2089x1764px, fundus photo — 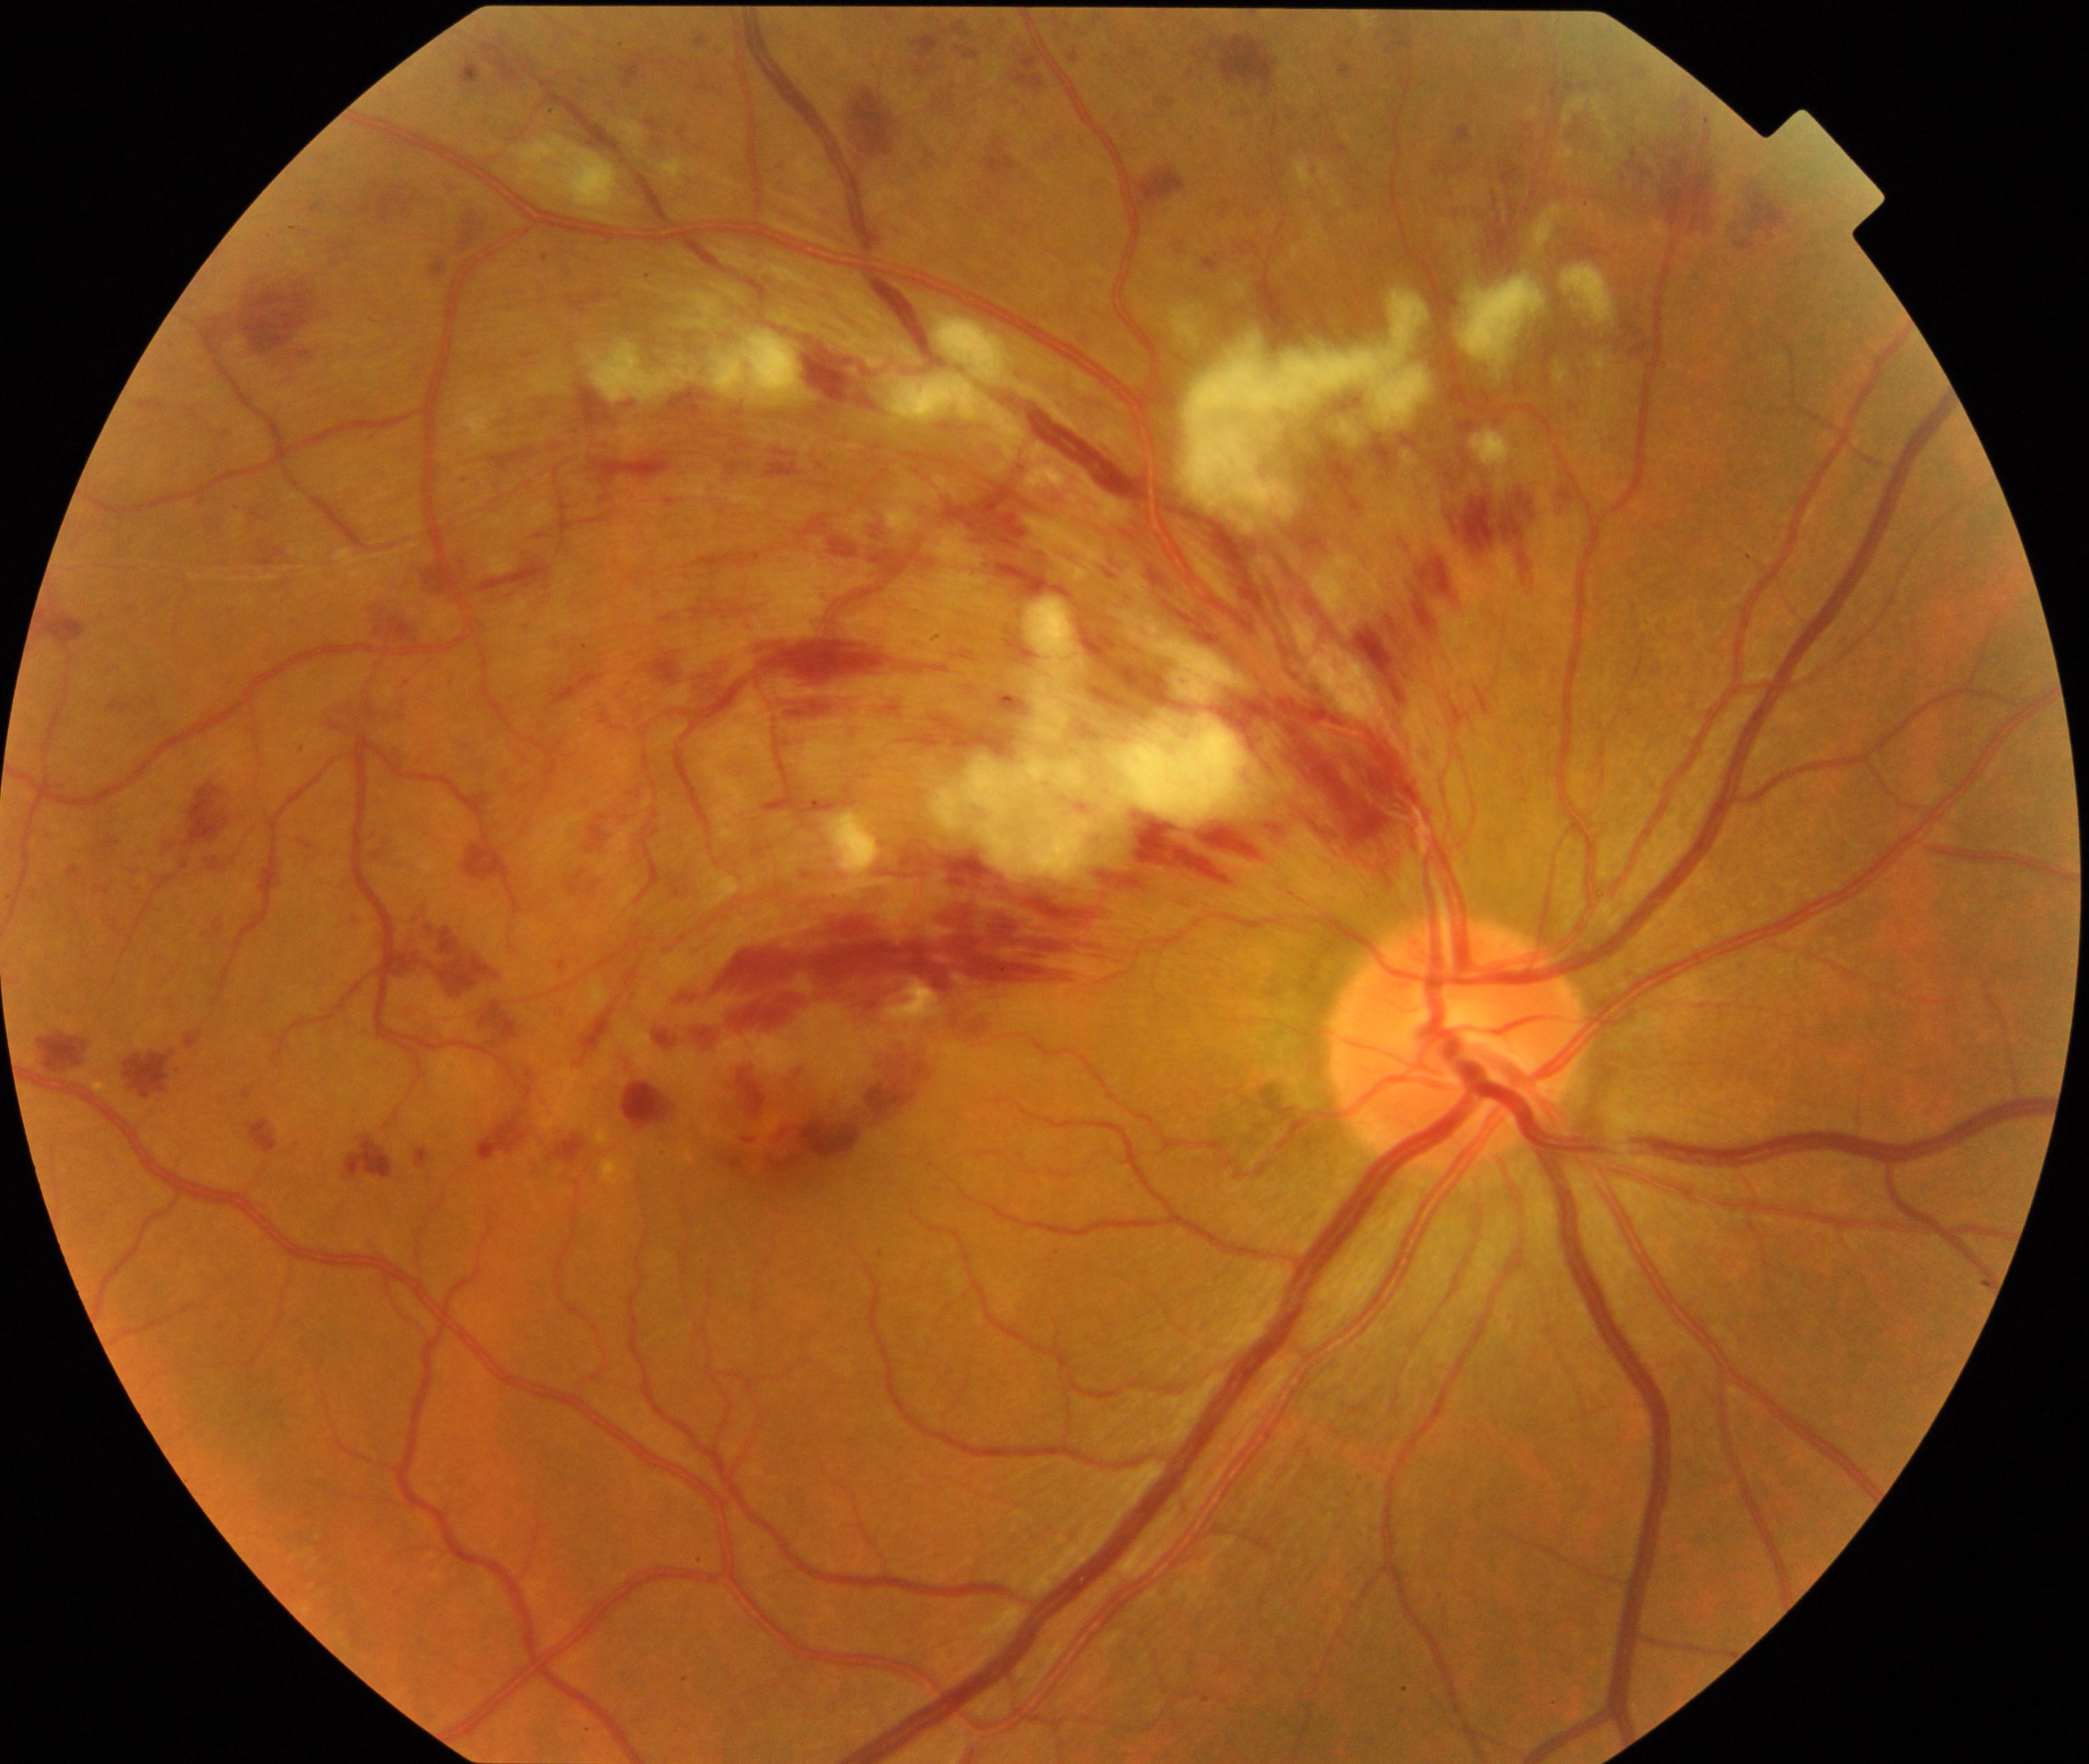

Primary finding: branch retinal vein occlusion (BRVO).